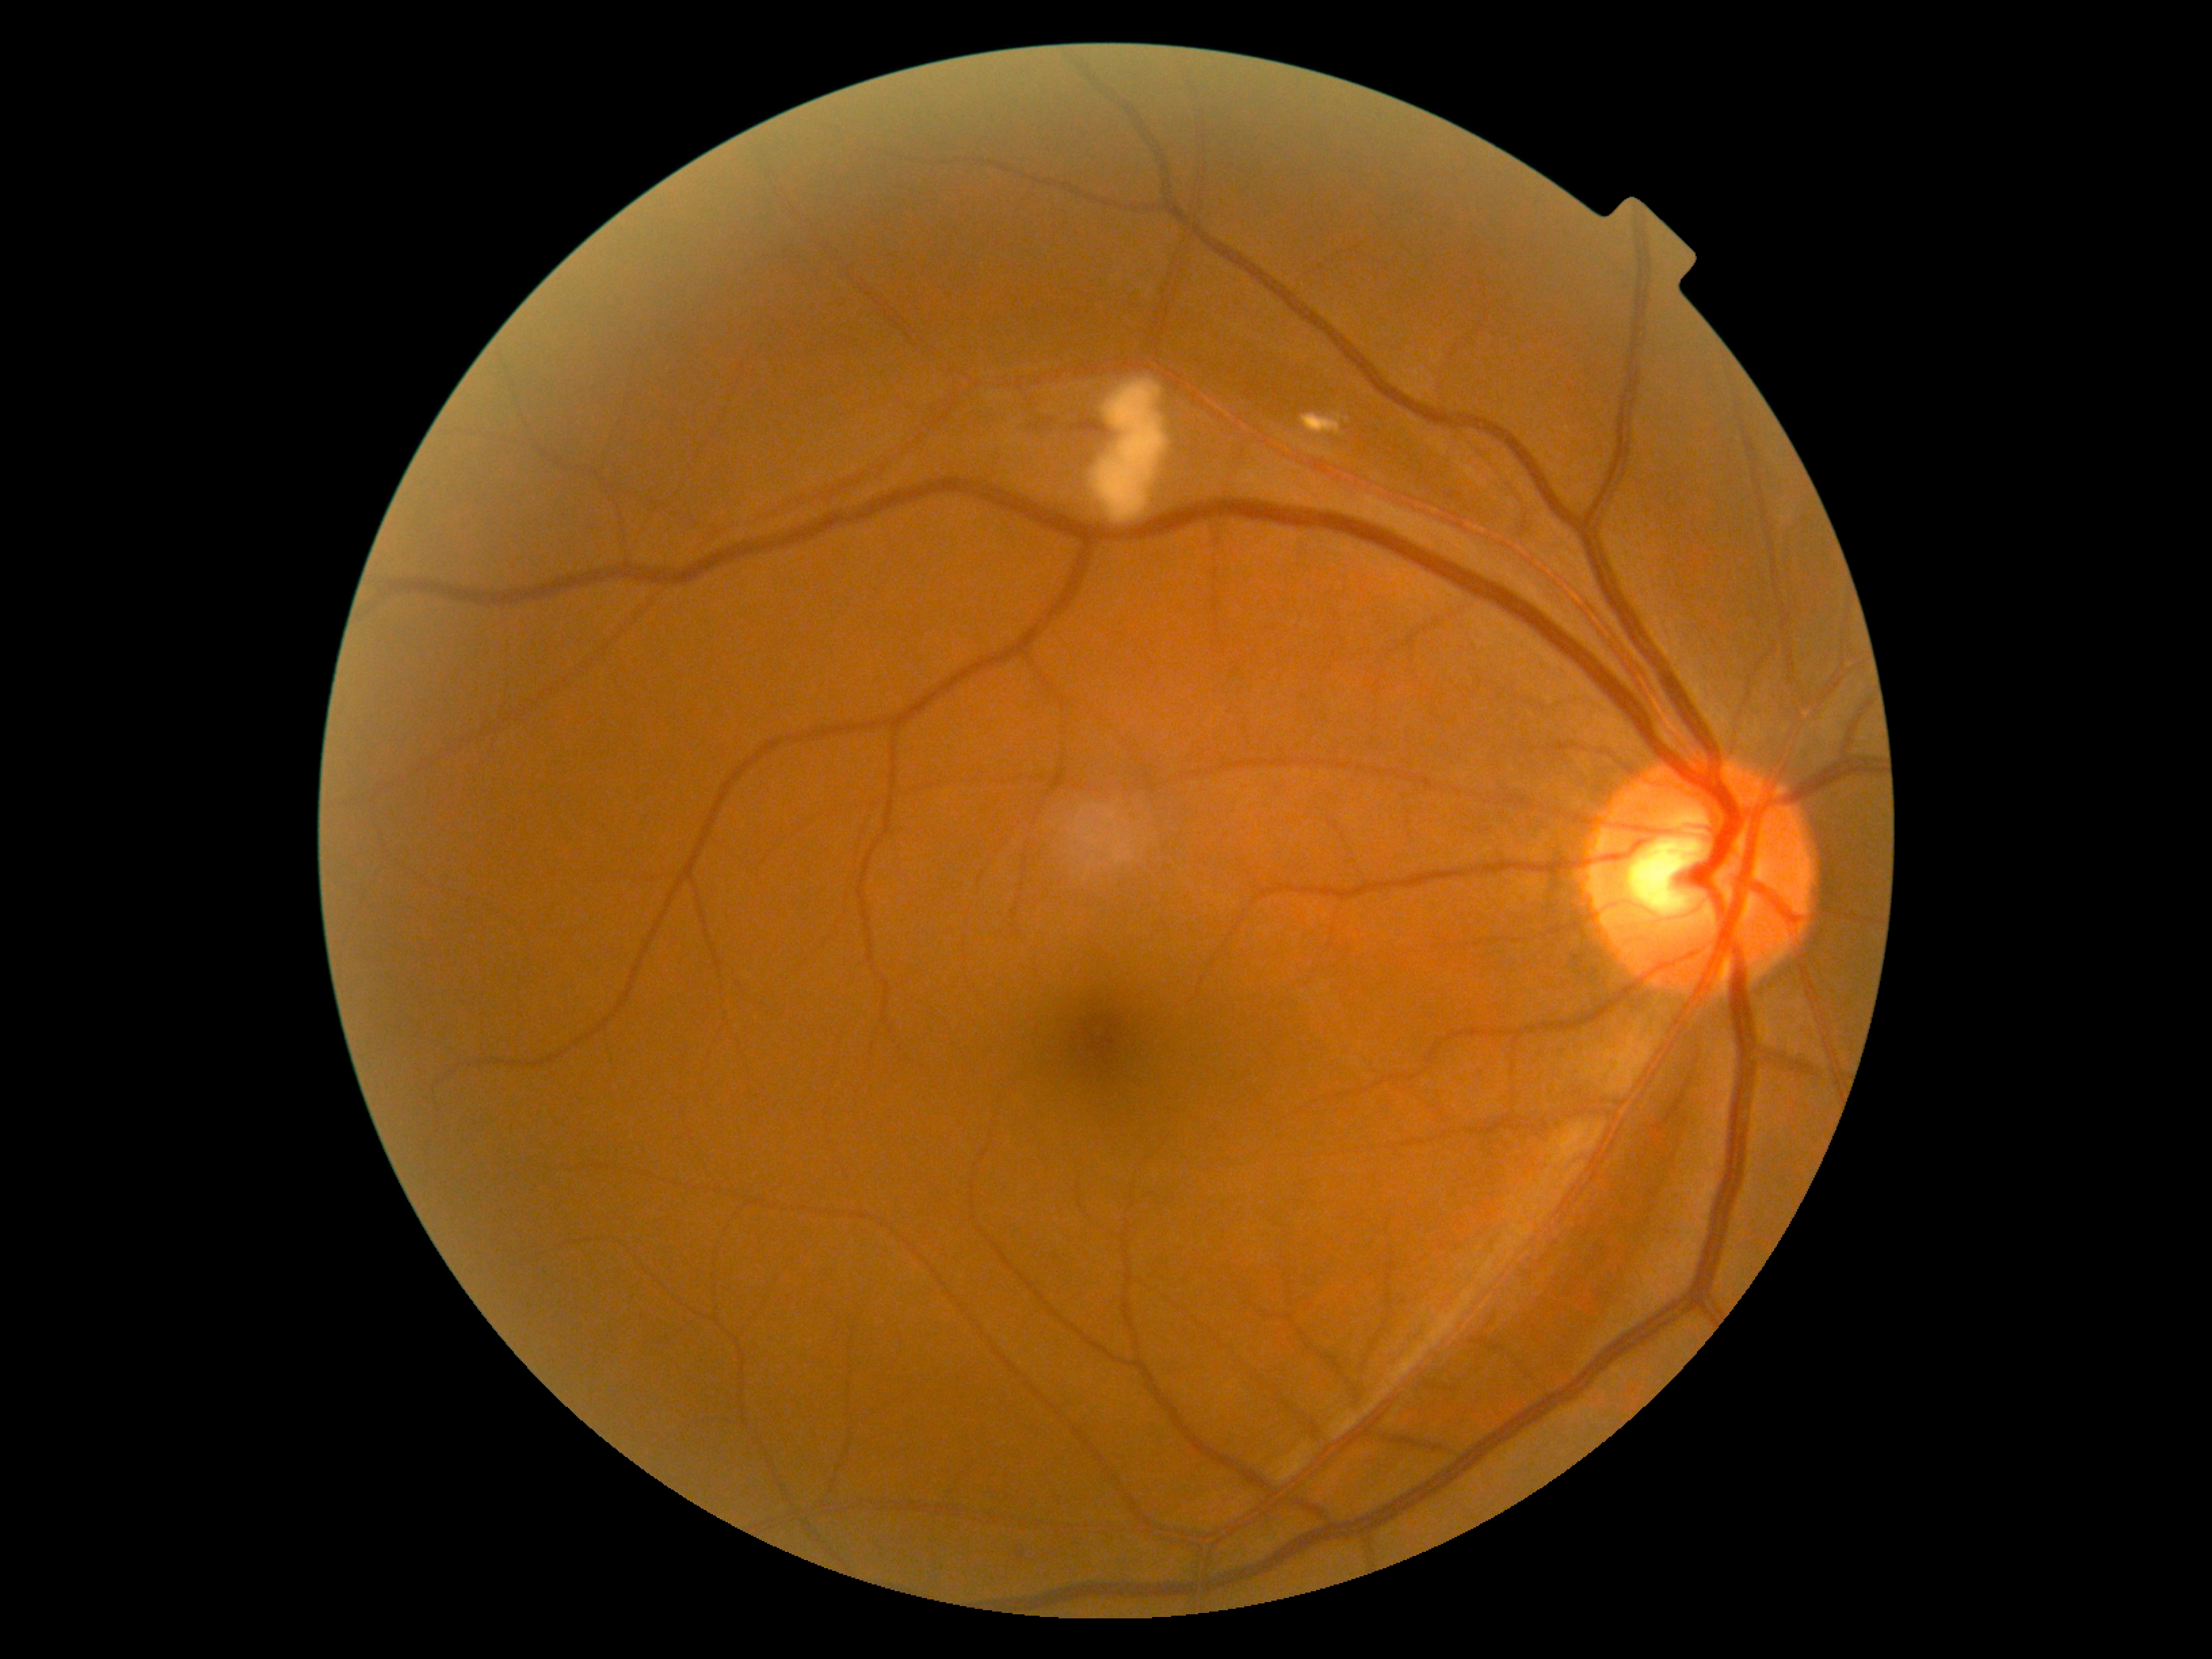

Diabetic retinopathy severity is 2/4.